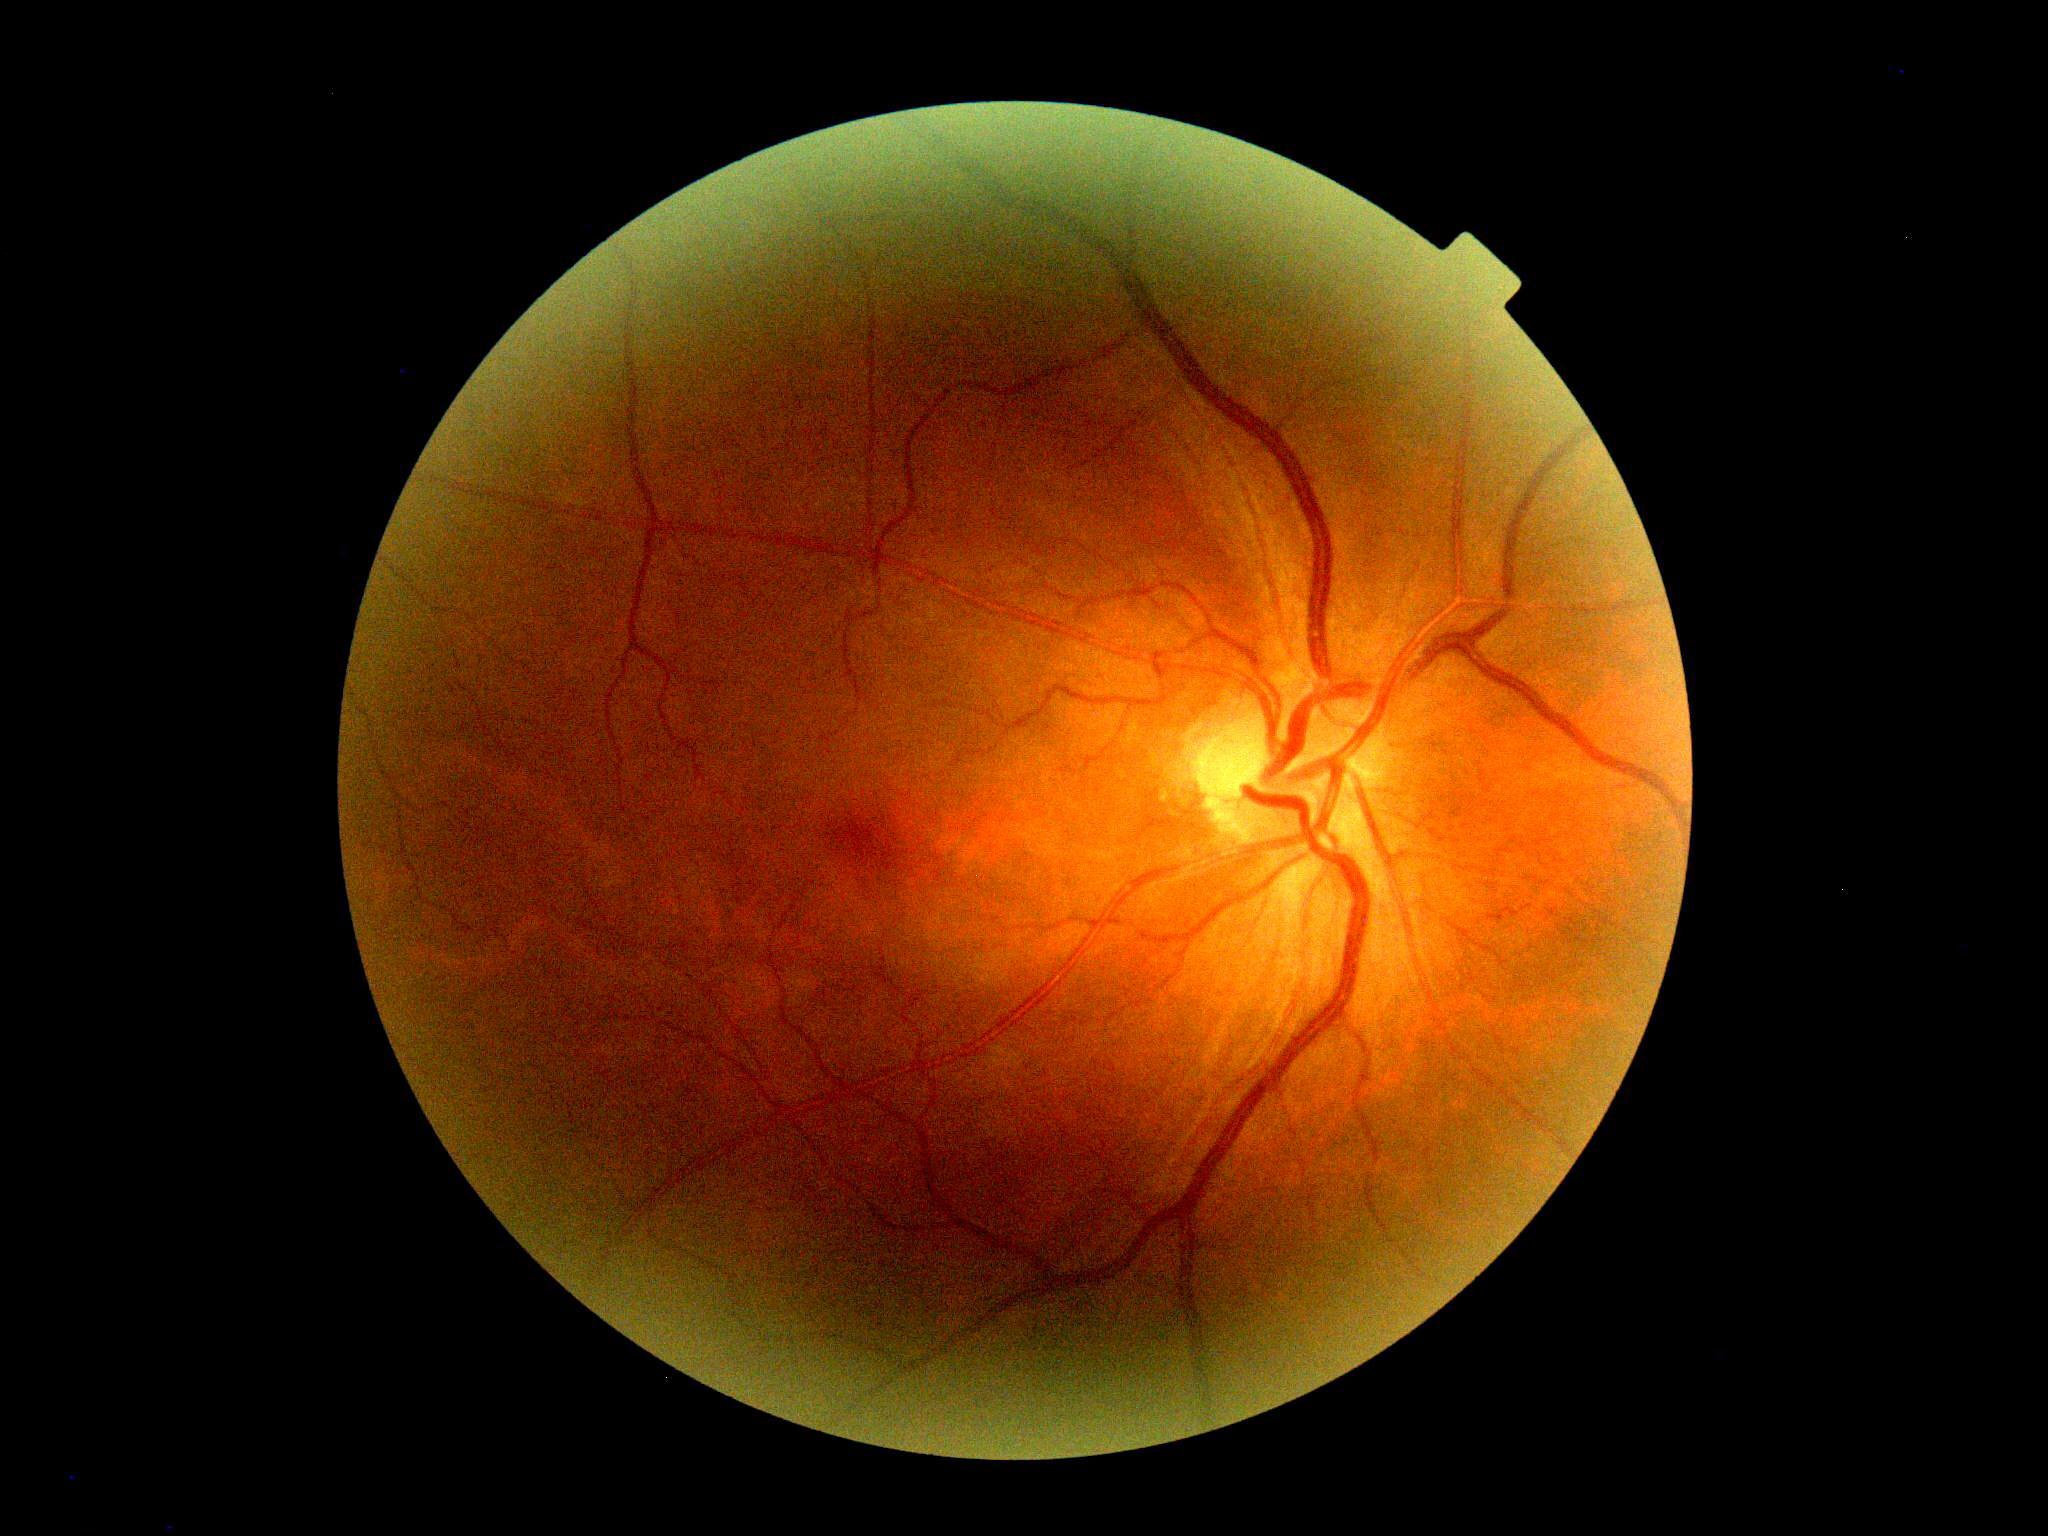 DR is no apparent diabetic retinopathy (grade 0).